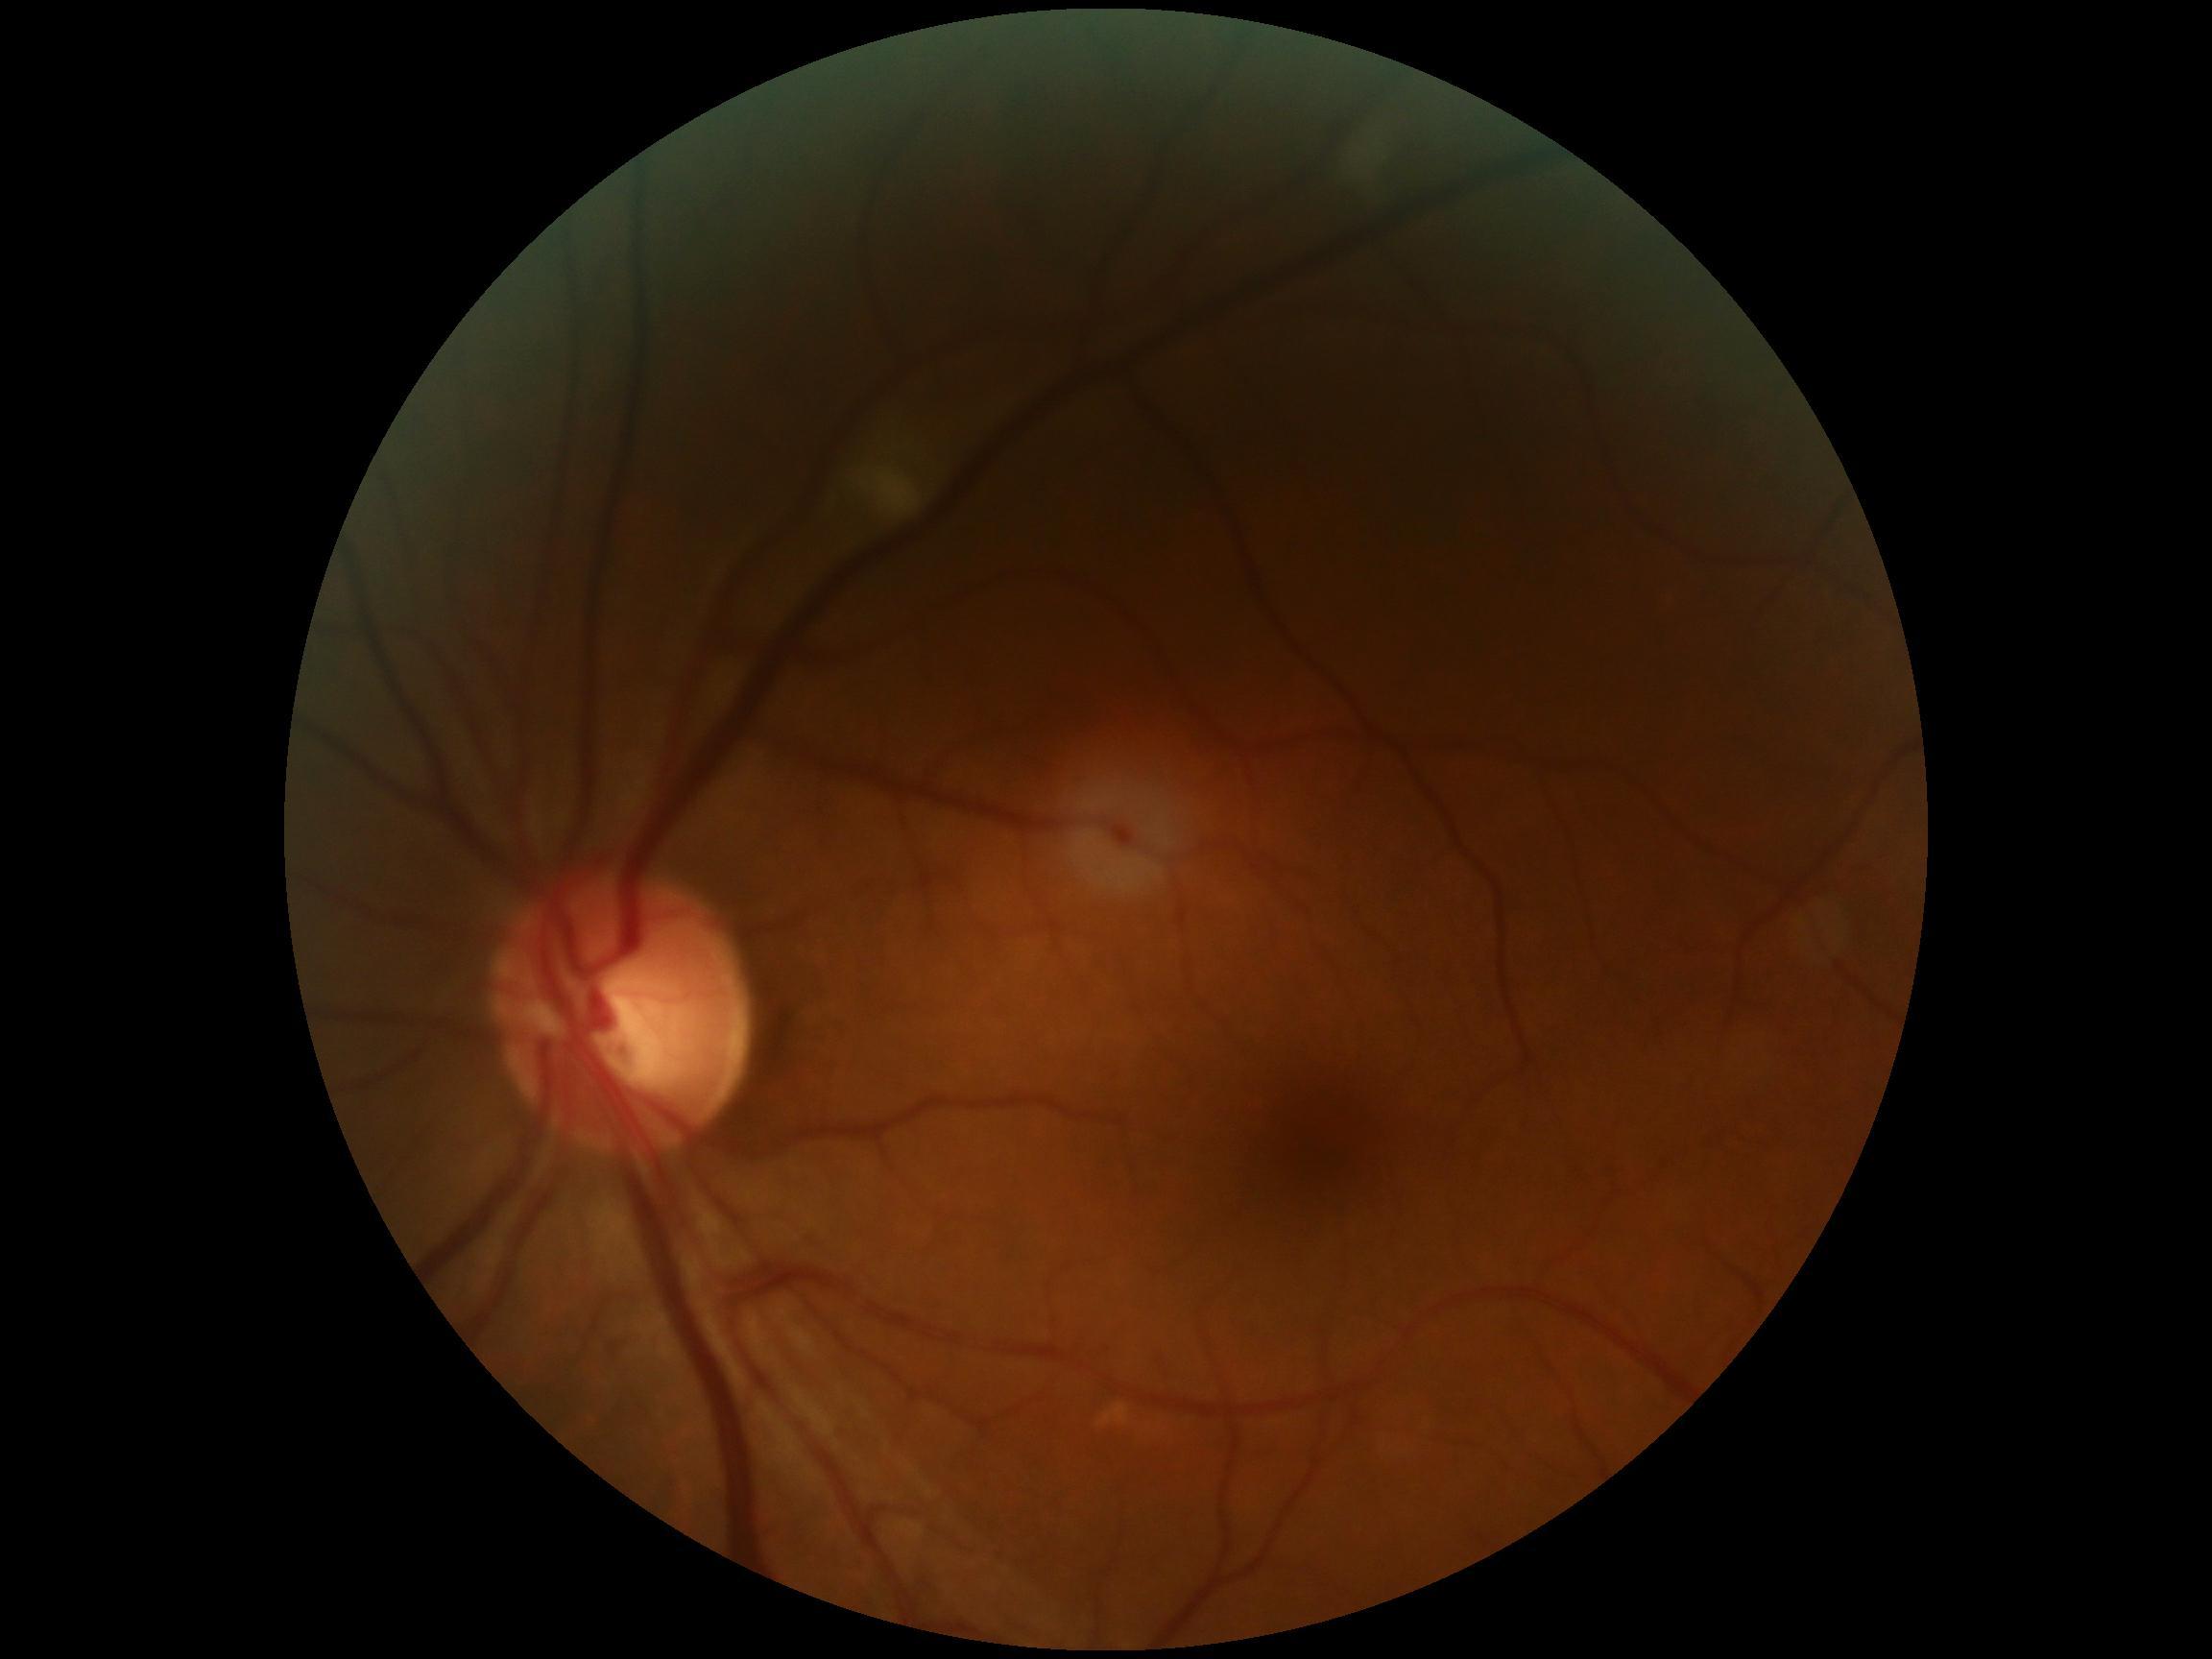 Retinopathy grade is 2 (moderate NPDR).